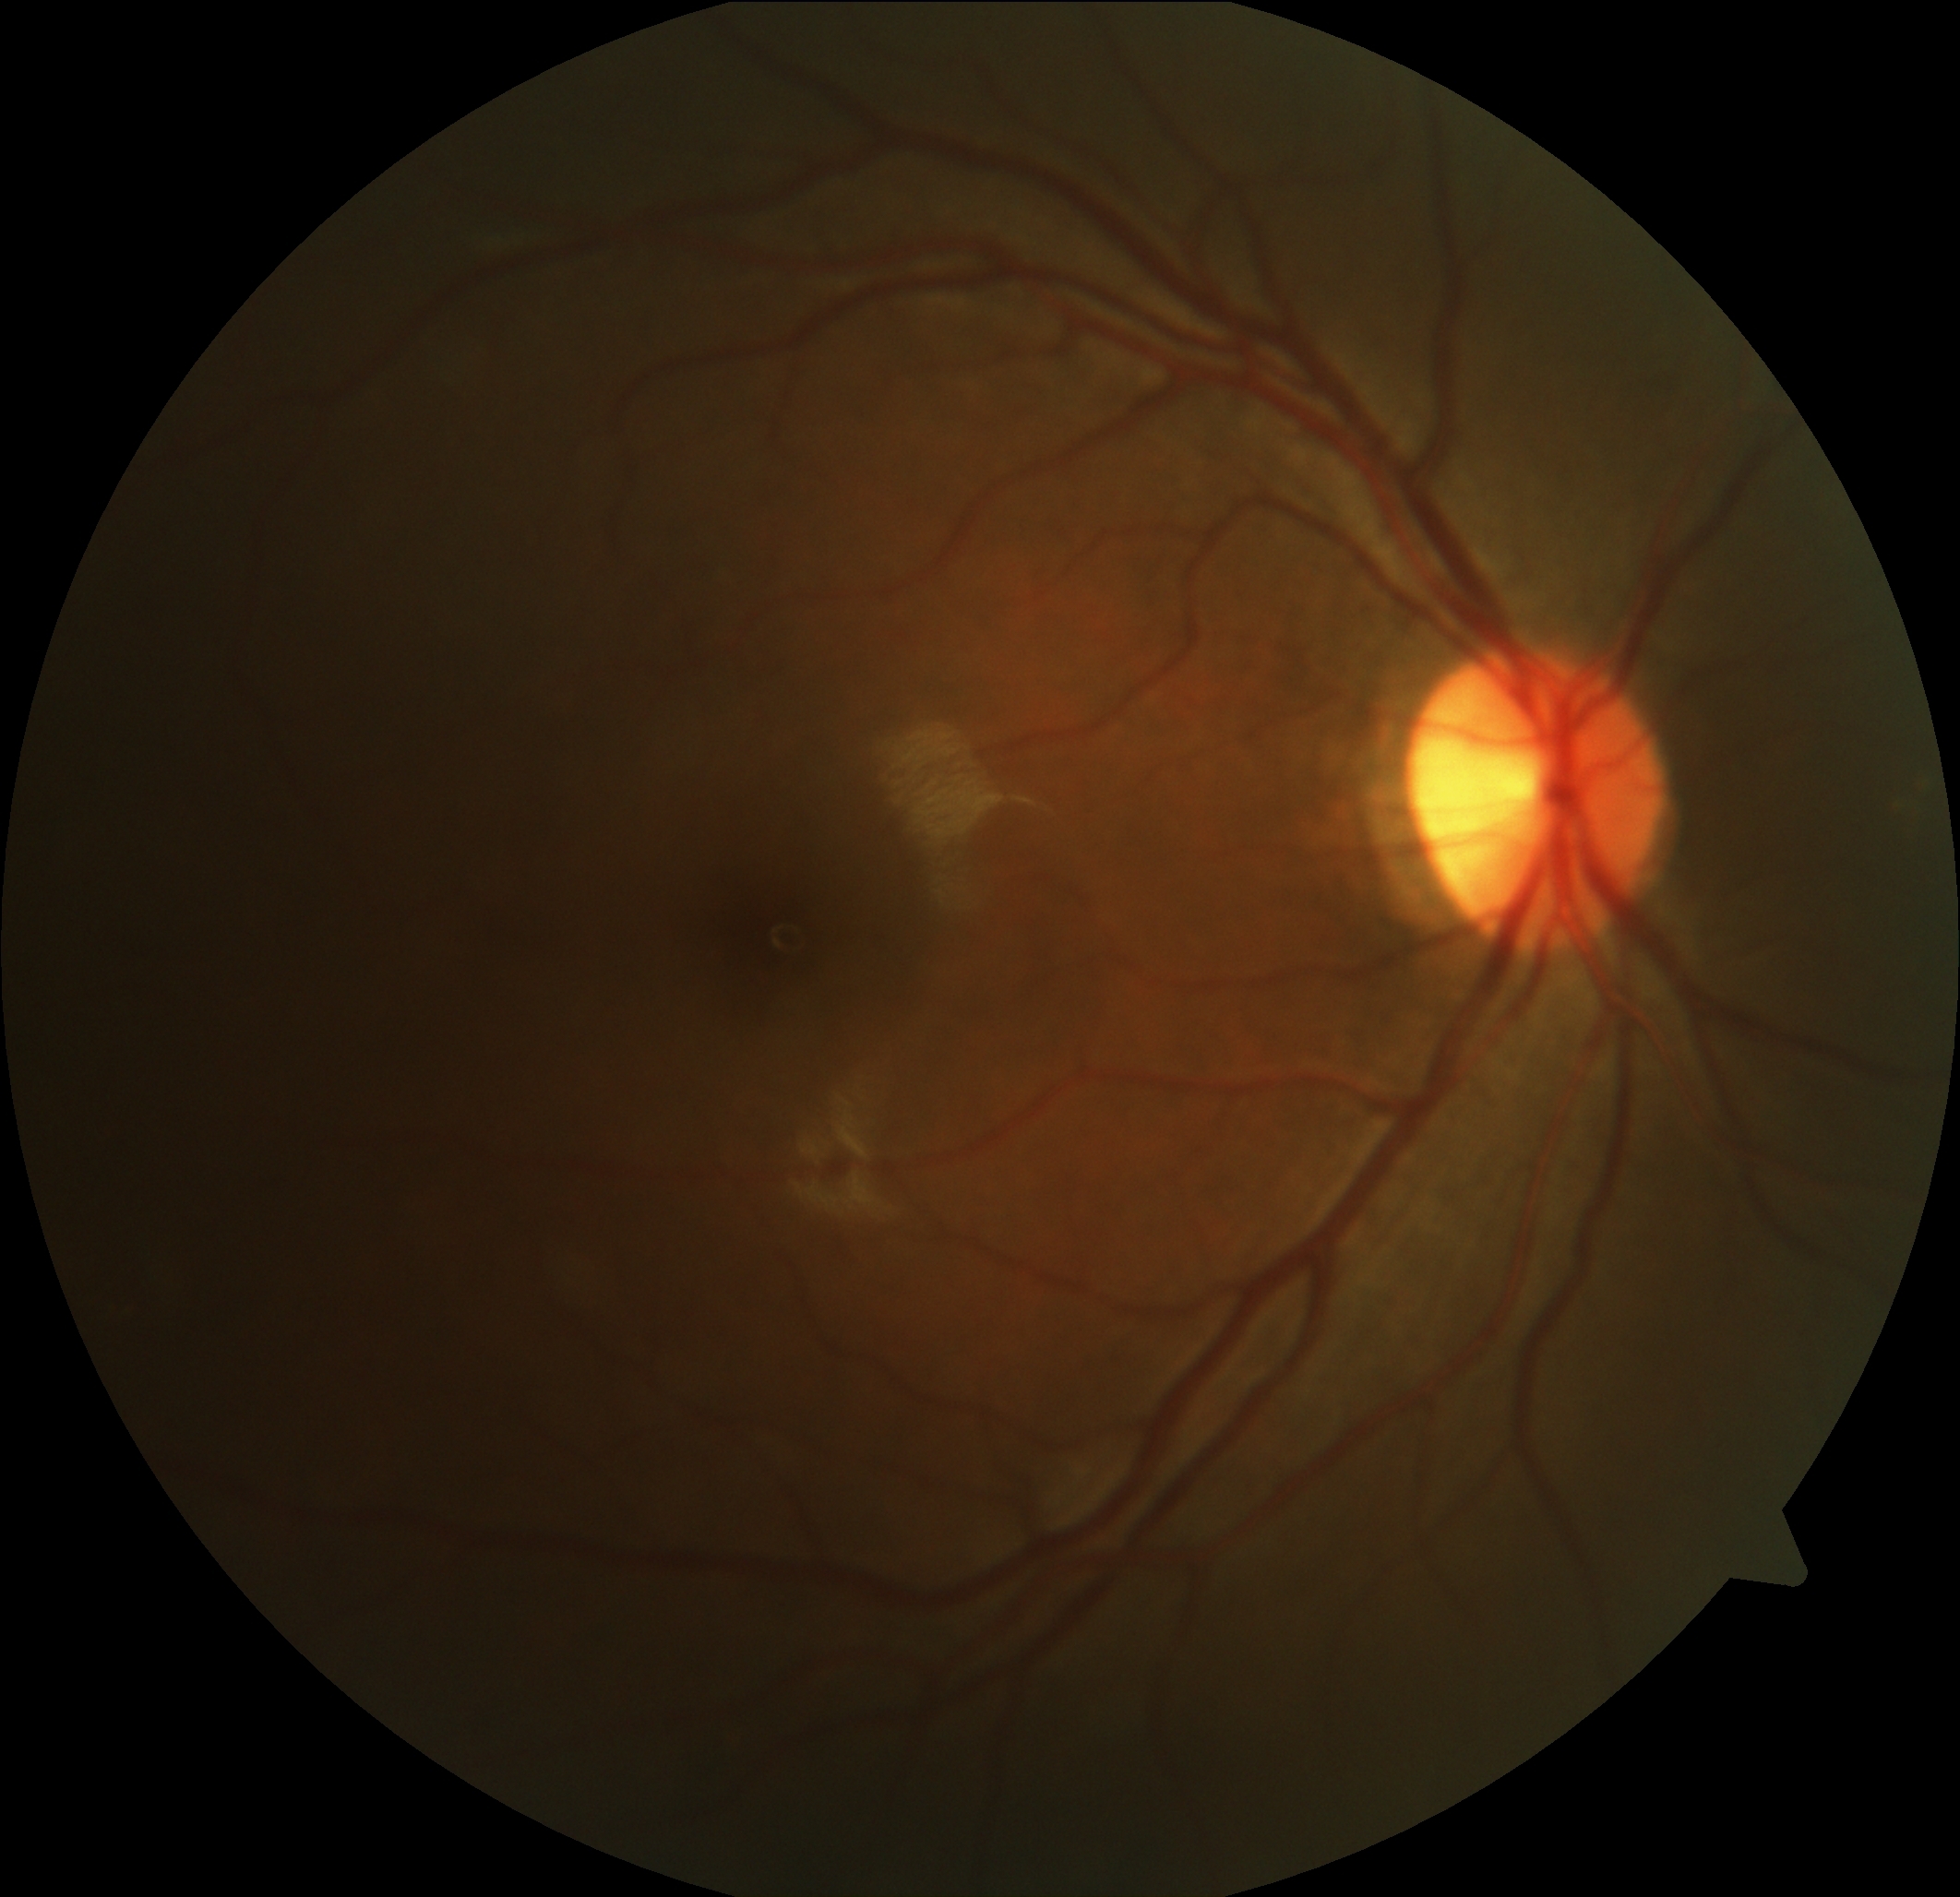
Findings:
– diabetic retinopathy: grade 0 (no apparent retinopathy) — no visible signs of diabetic retinopathy
– DR impression: negative for DR